2212 x 1659 pixels:
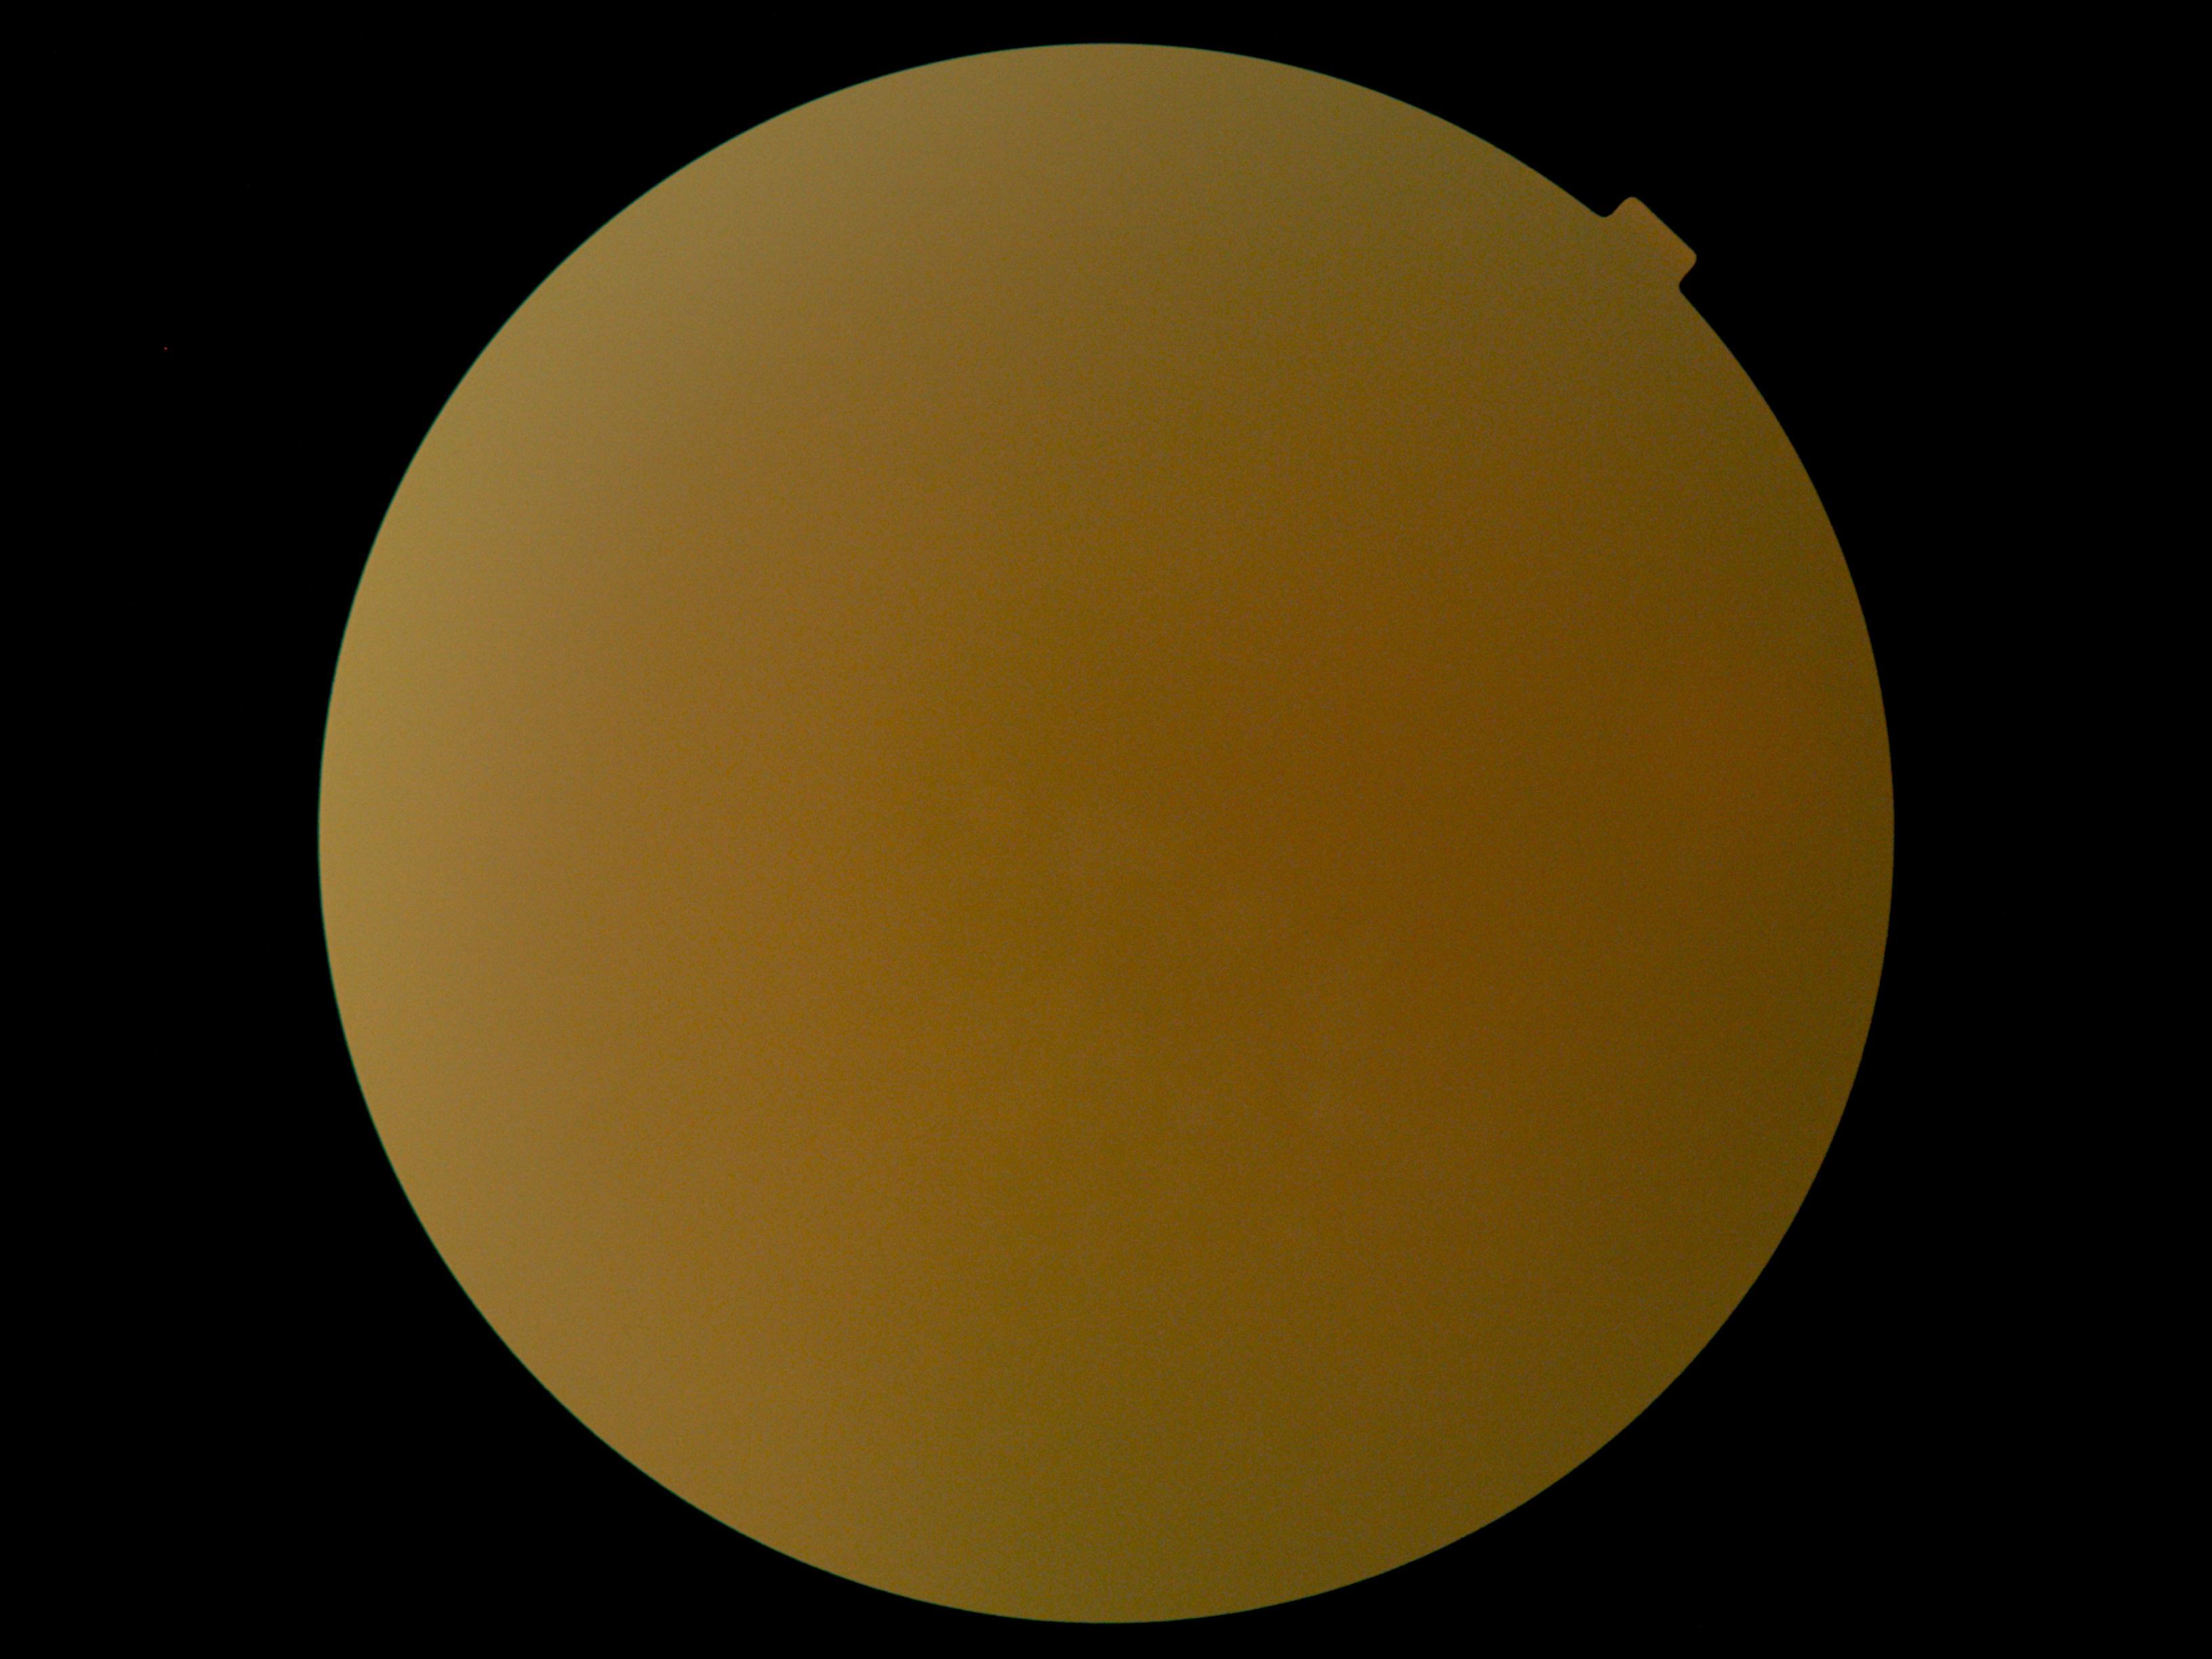
Retinopathy is ungradable due to poor image quality.